45° field of view
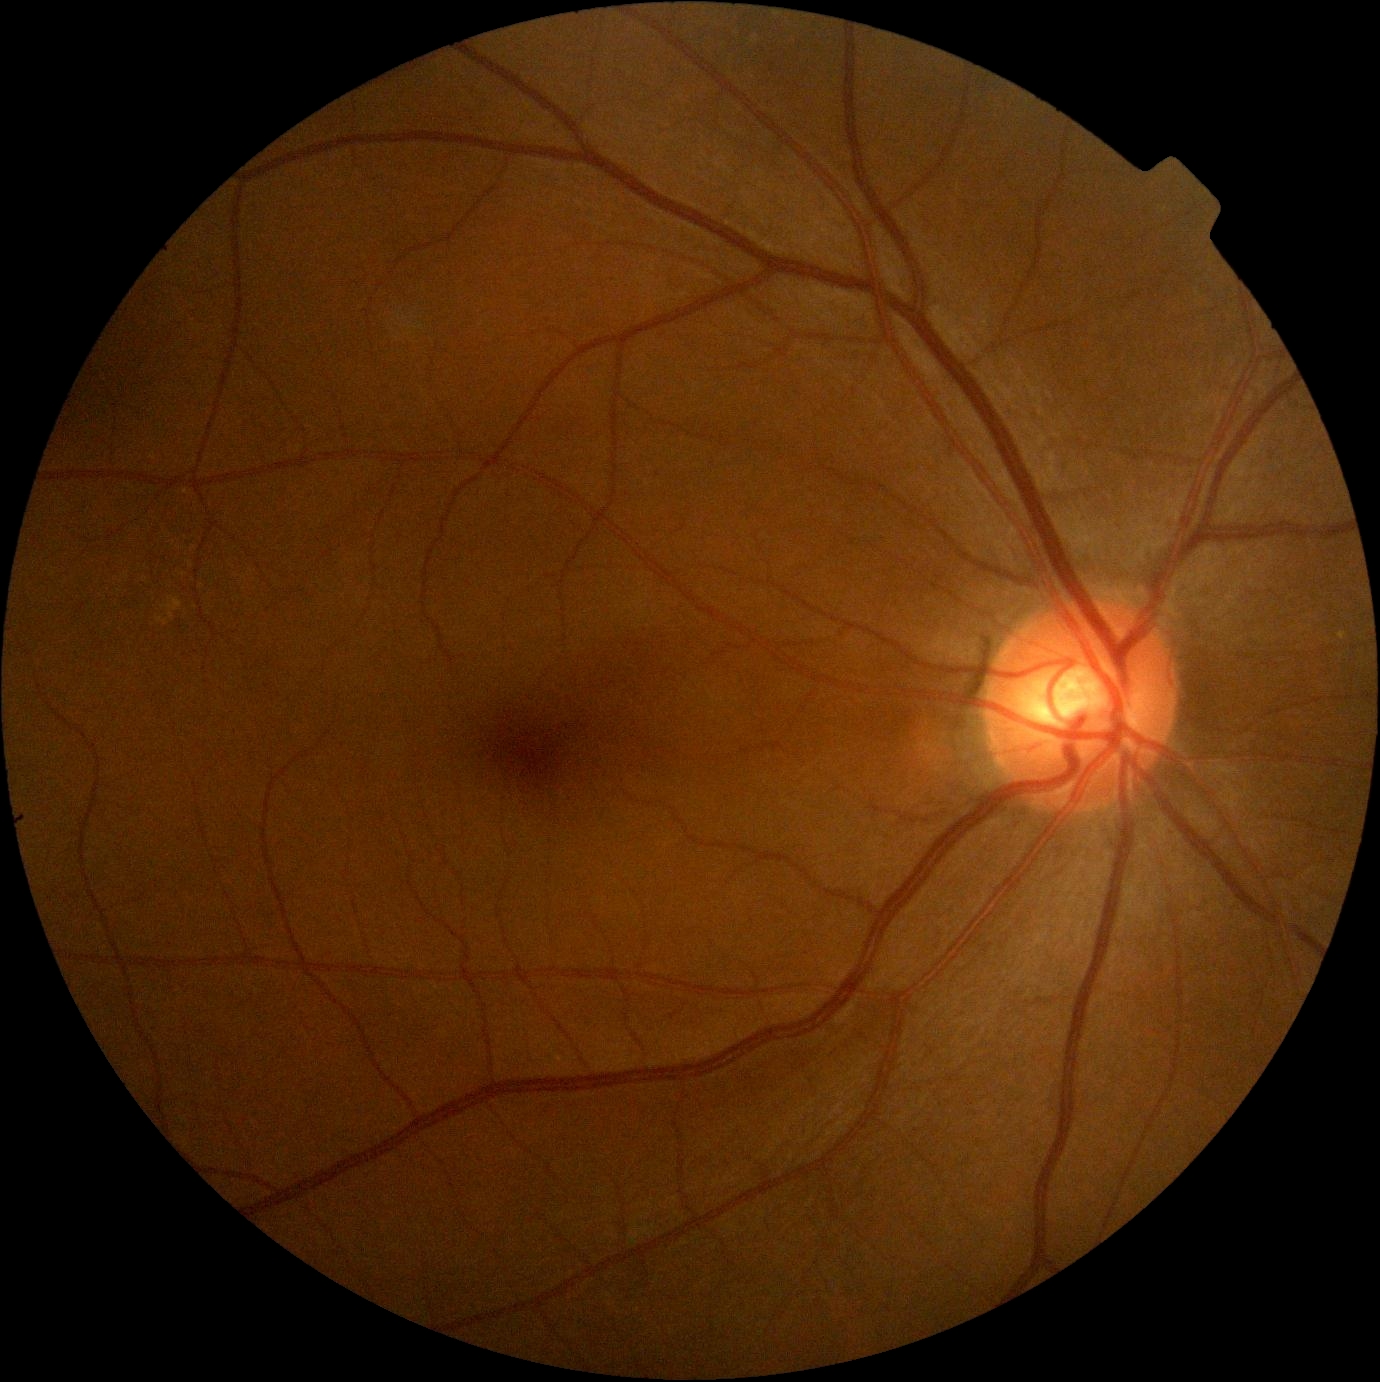
DR stage: no apparent diabetic retinopathy (grade 0).